1380 x 1382 pixels:
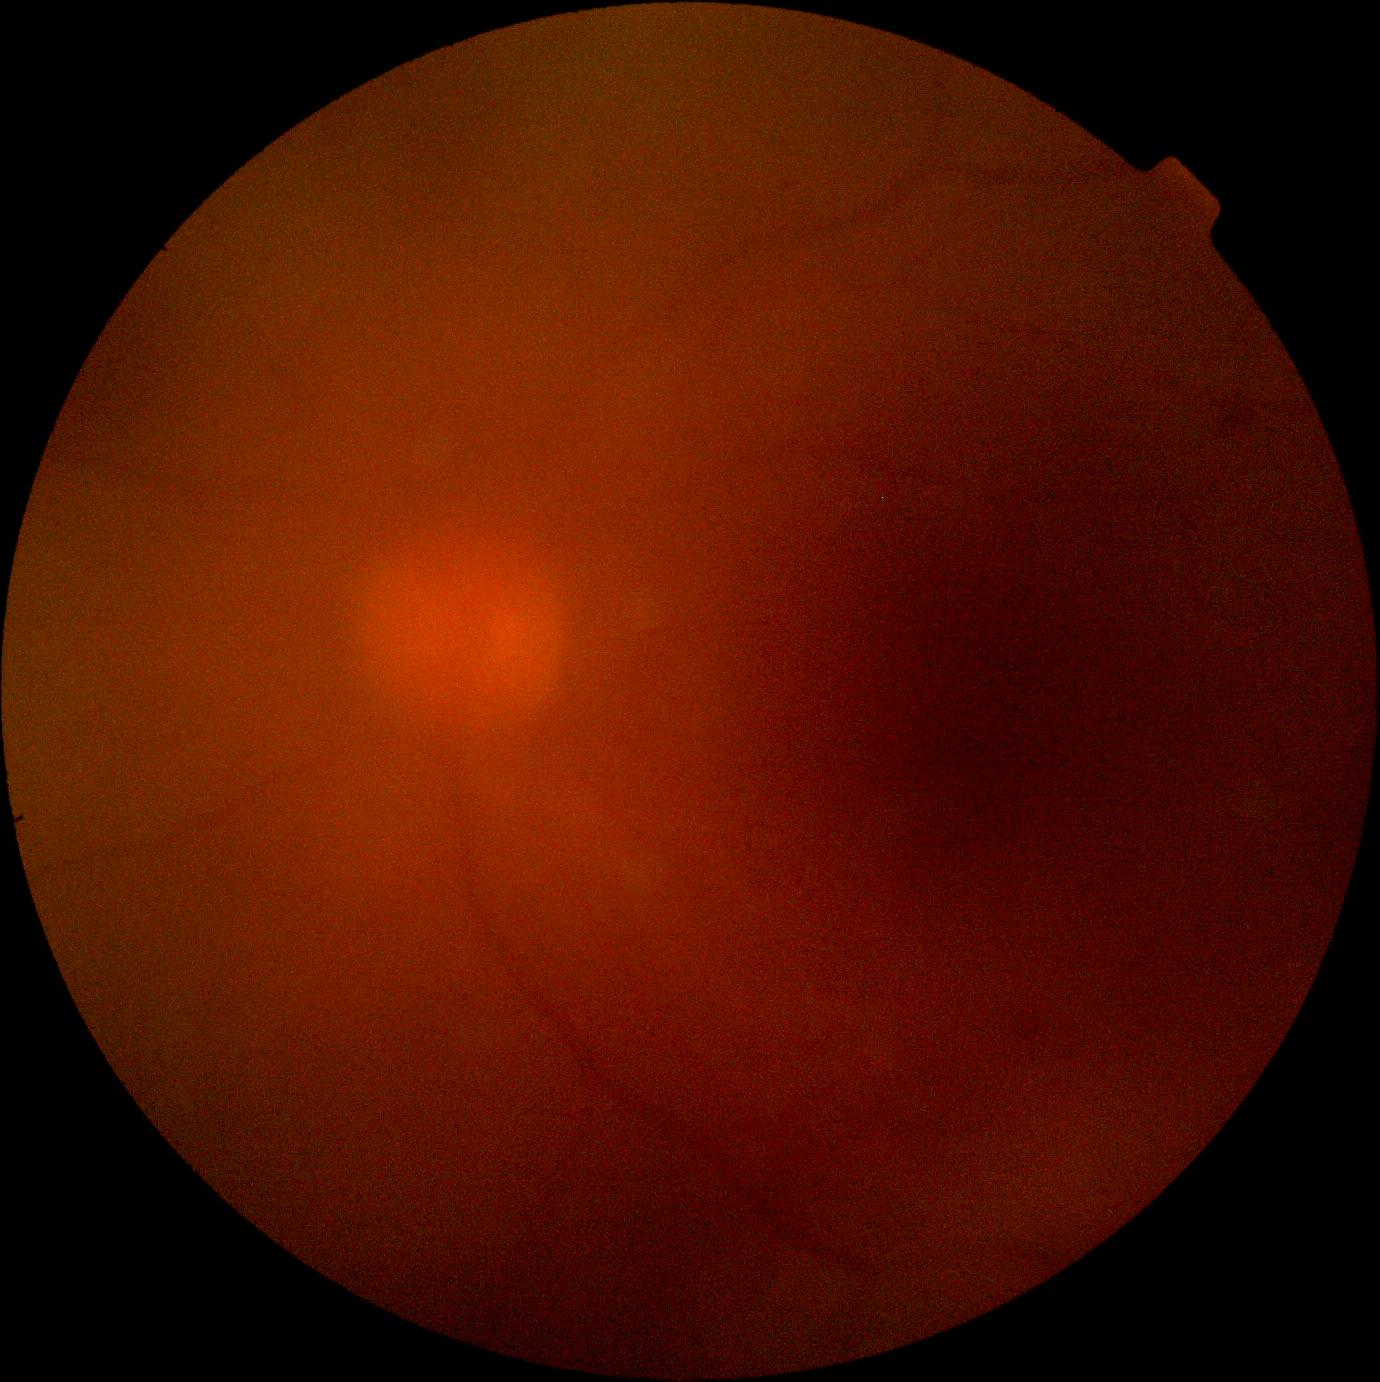
image quality = insufficient; DR stage = ungradable due to poor image quality.